Image size 512x512. CFP — 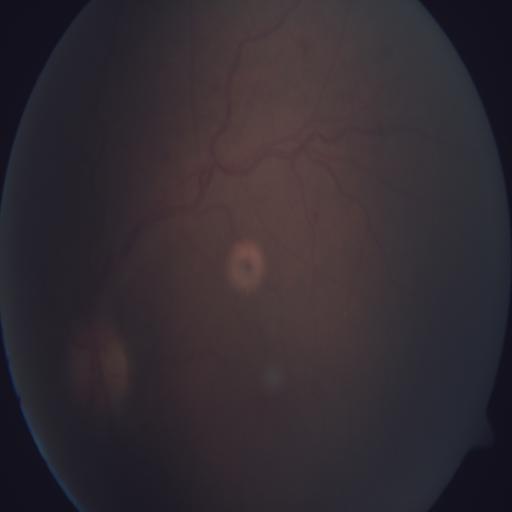

Pathology: TV (tortuous vessels).